512x512px.
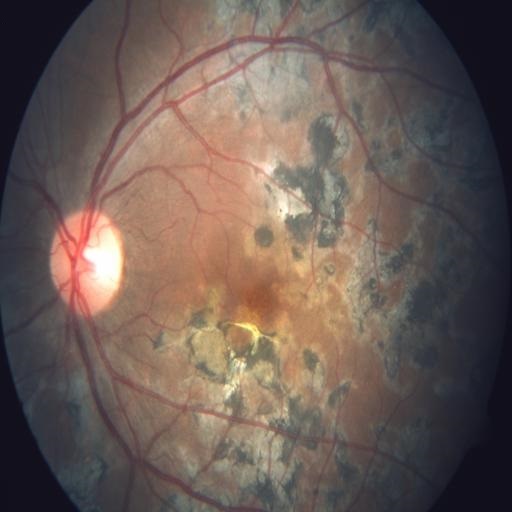
Pathology: chorioretinitis.